Image size 2346x1568.
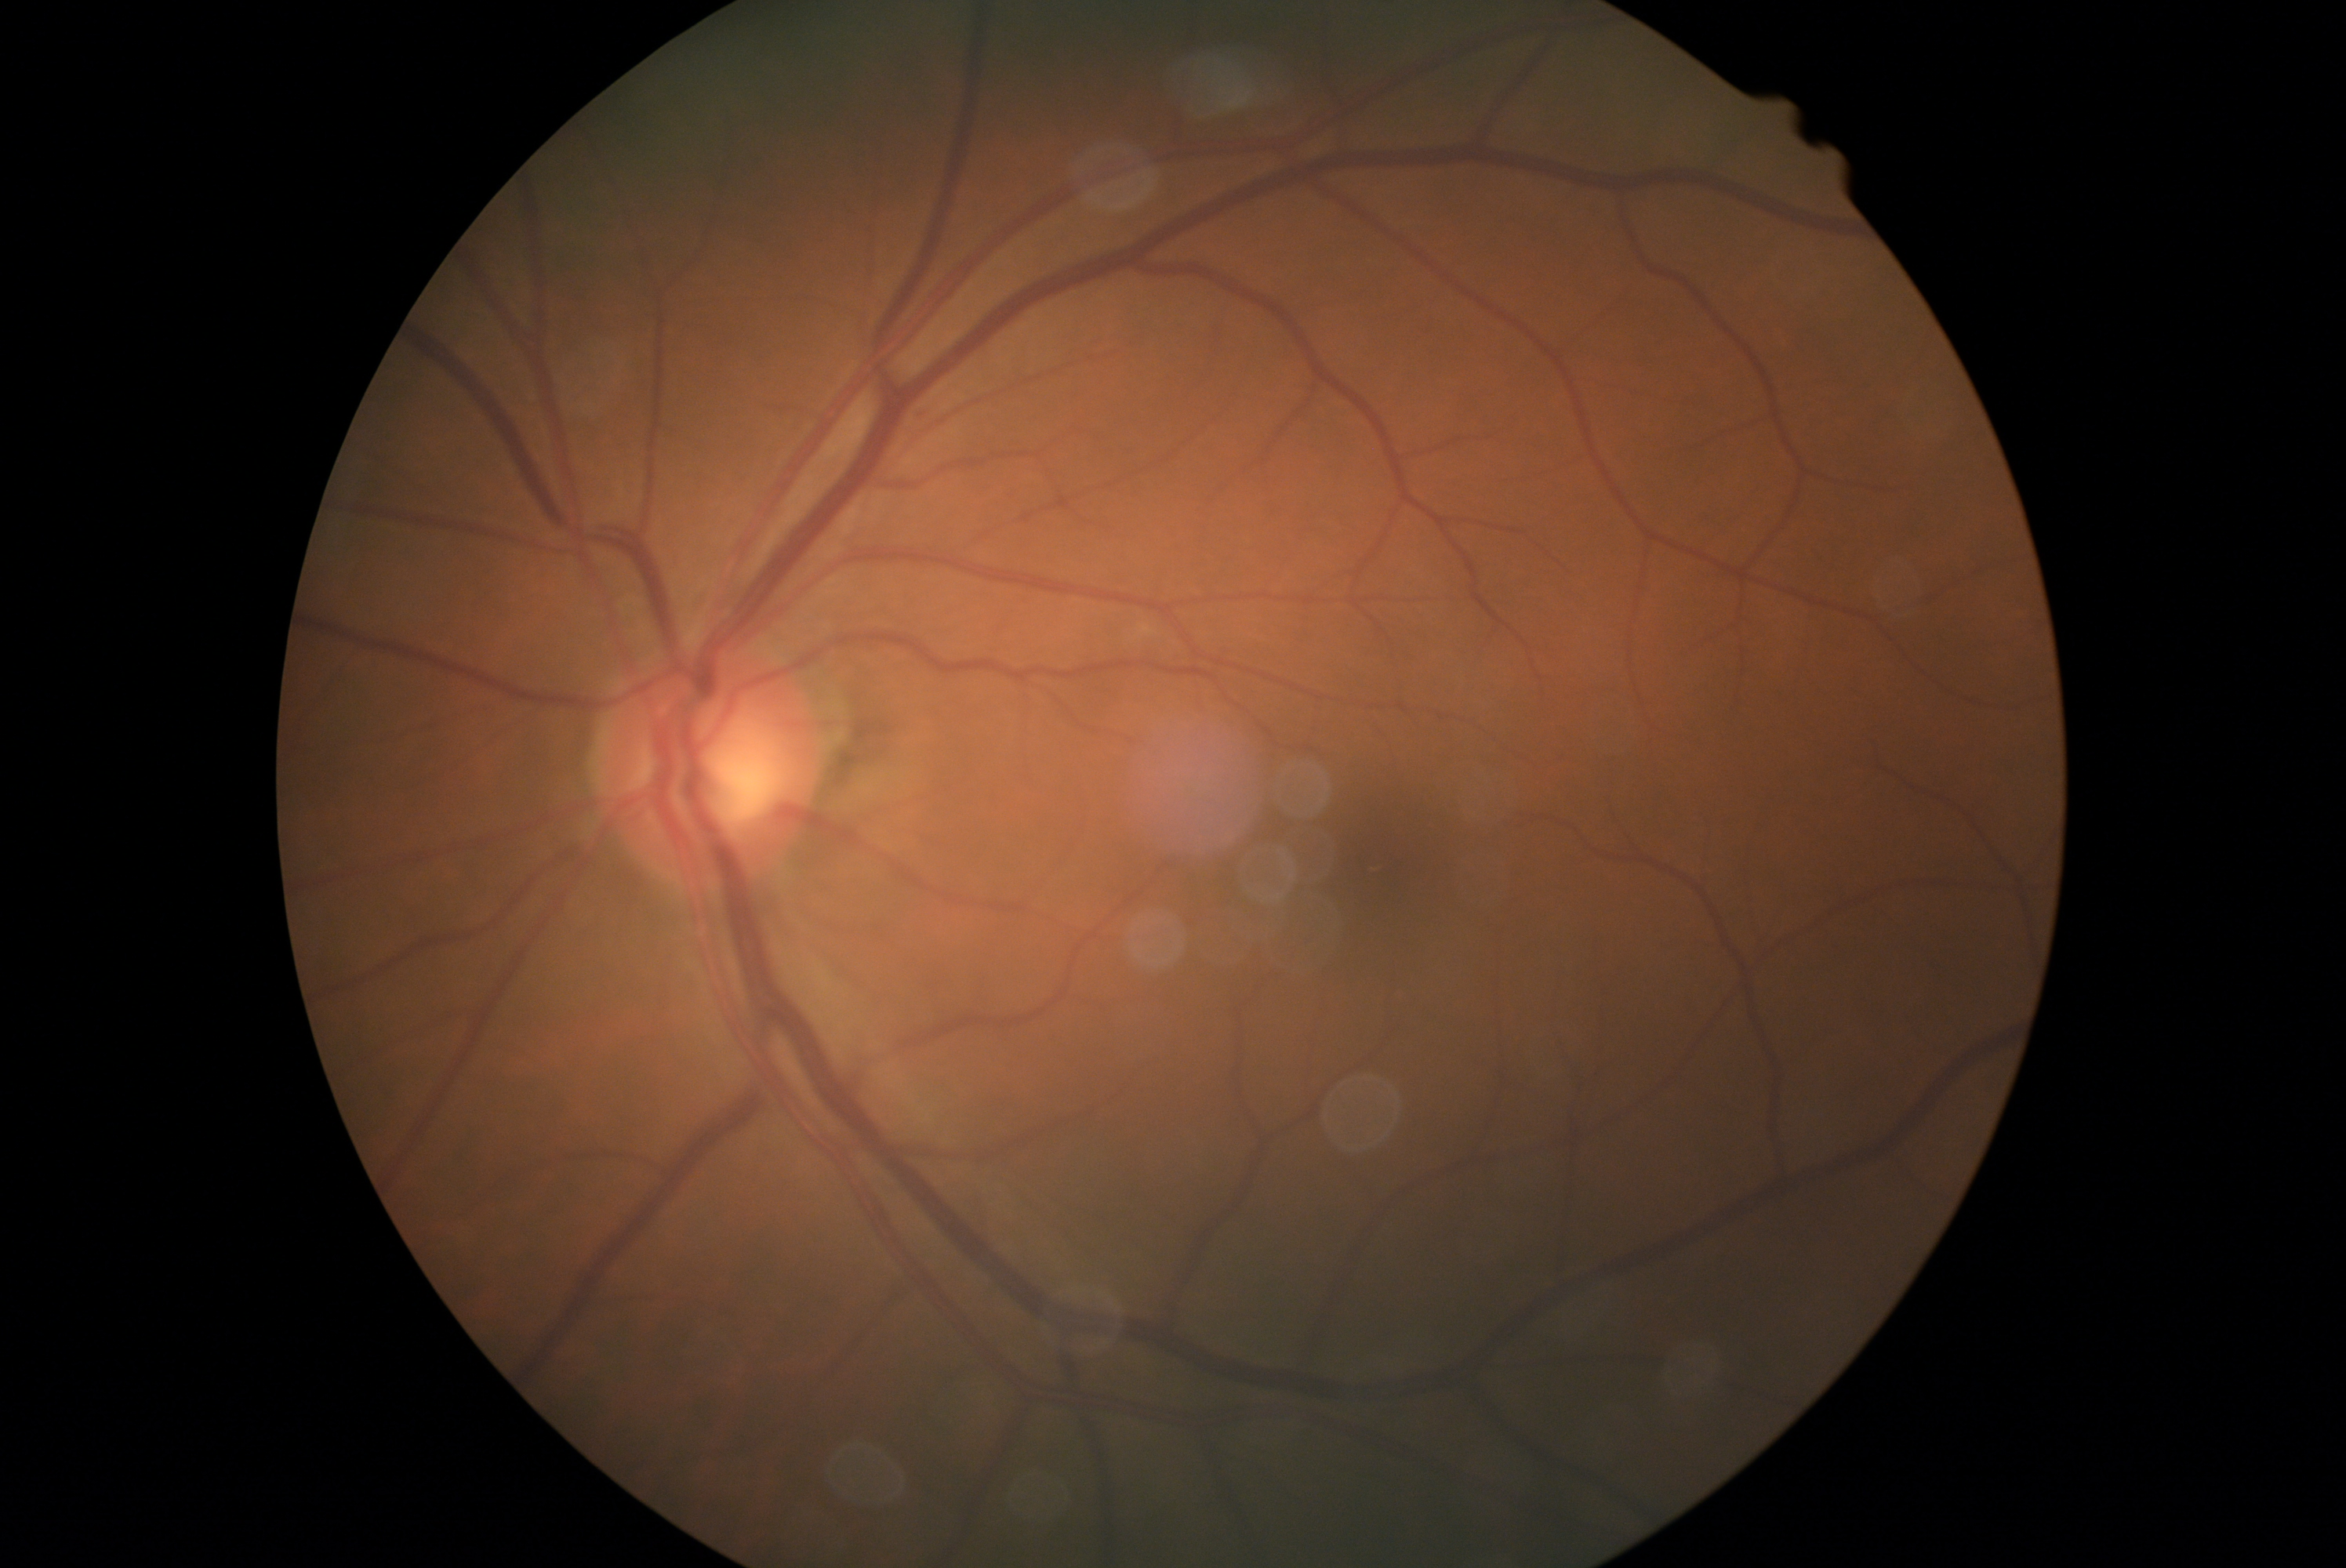
DR stage is grade 0 (no apparent retinopathy) — no visible signs of diabetic retinopathy.